Infant wide-field retinal image.
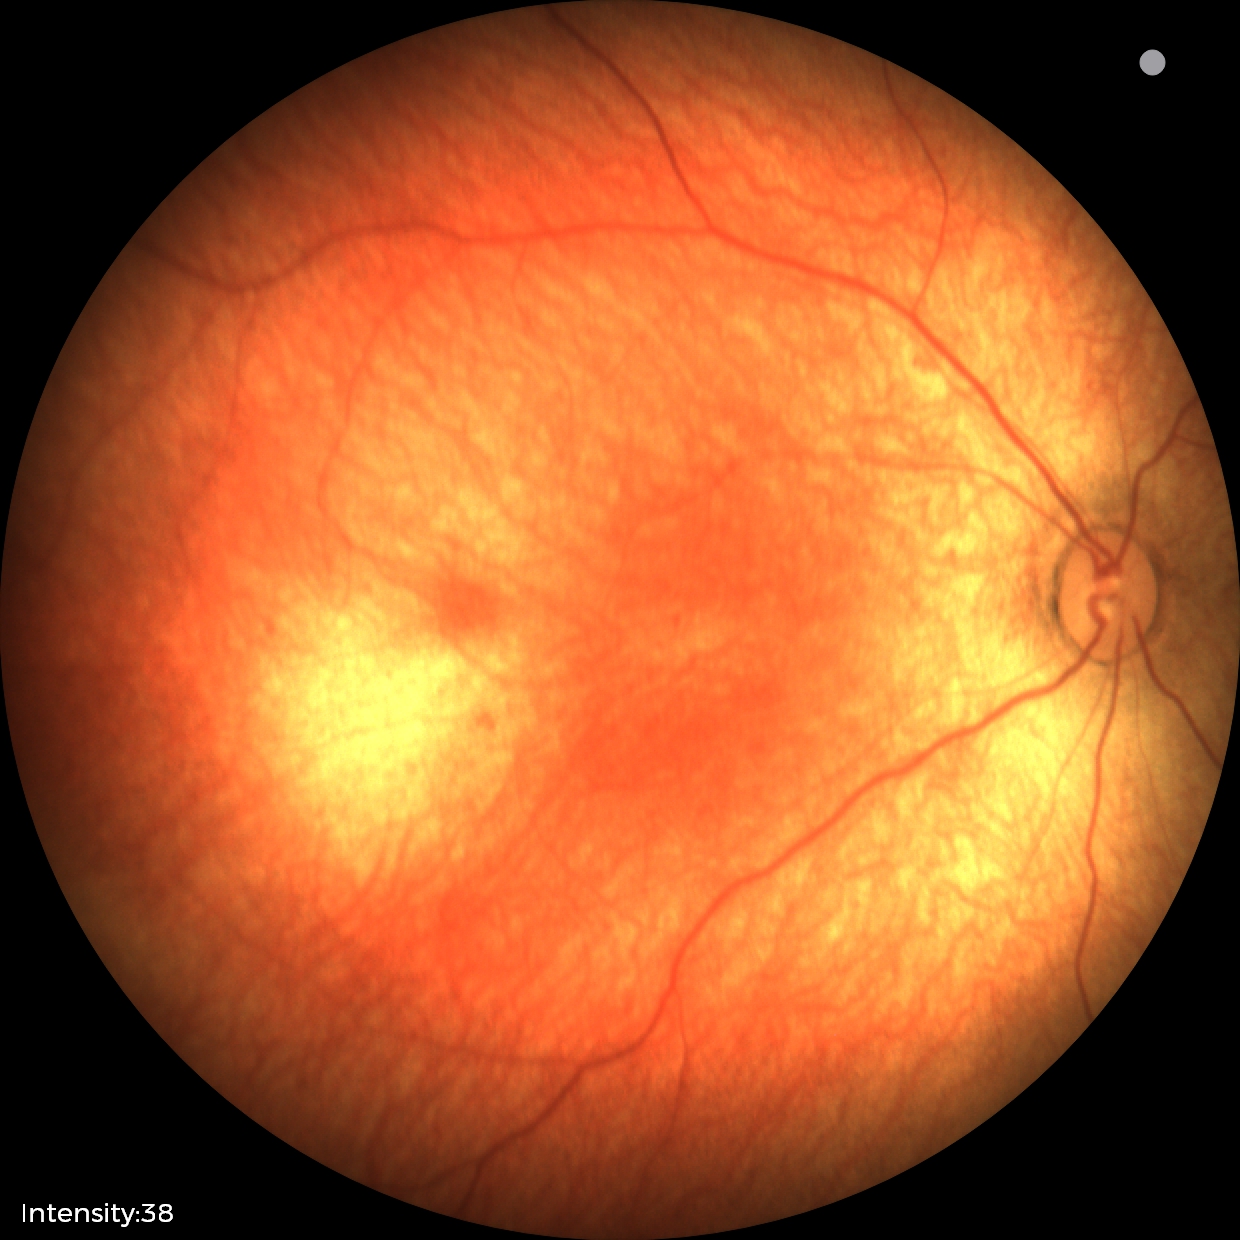
Screening examination with no abnormal retinal findings.